2352 x 1568 pixels: 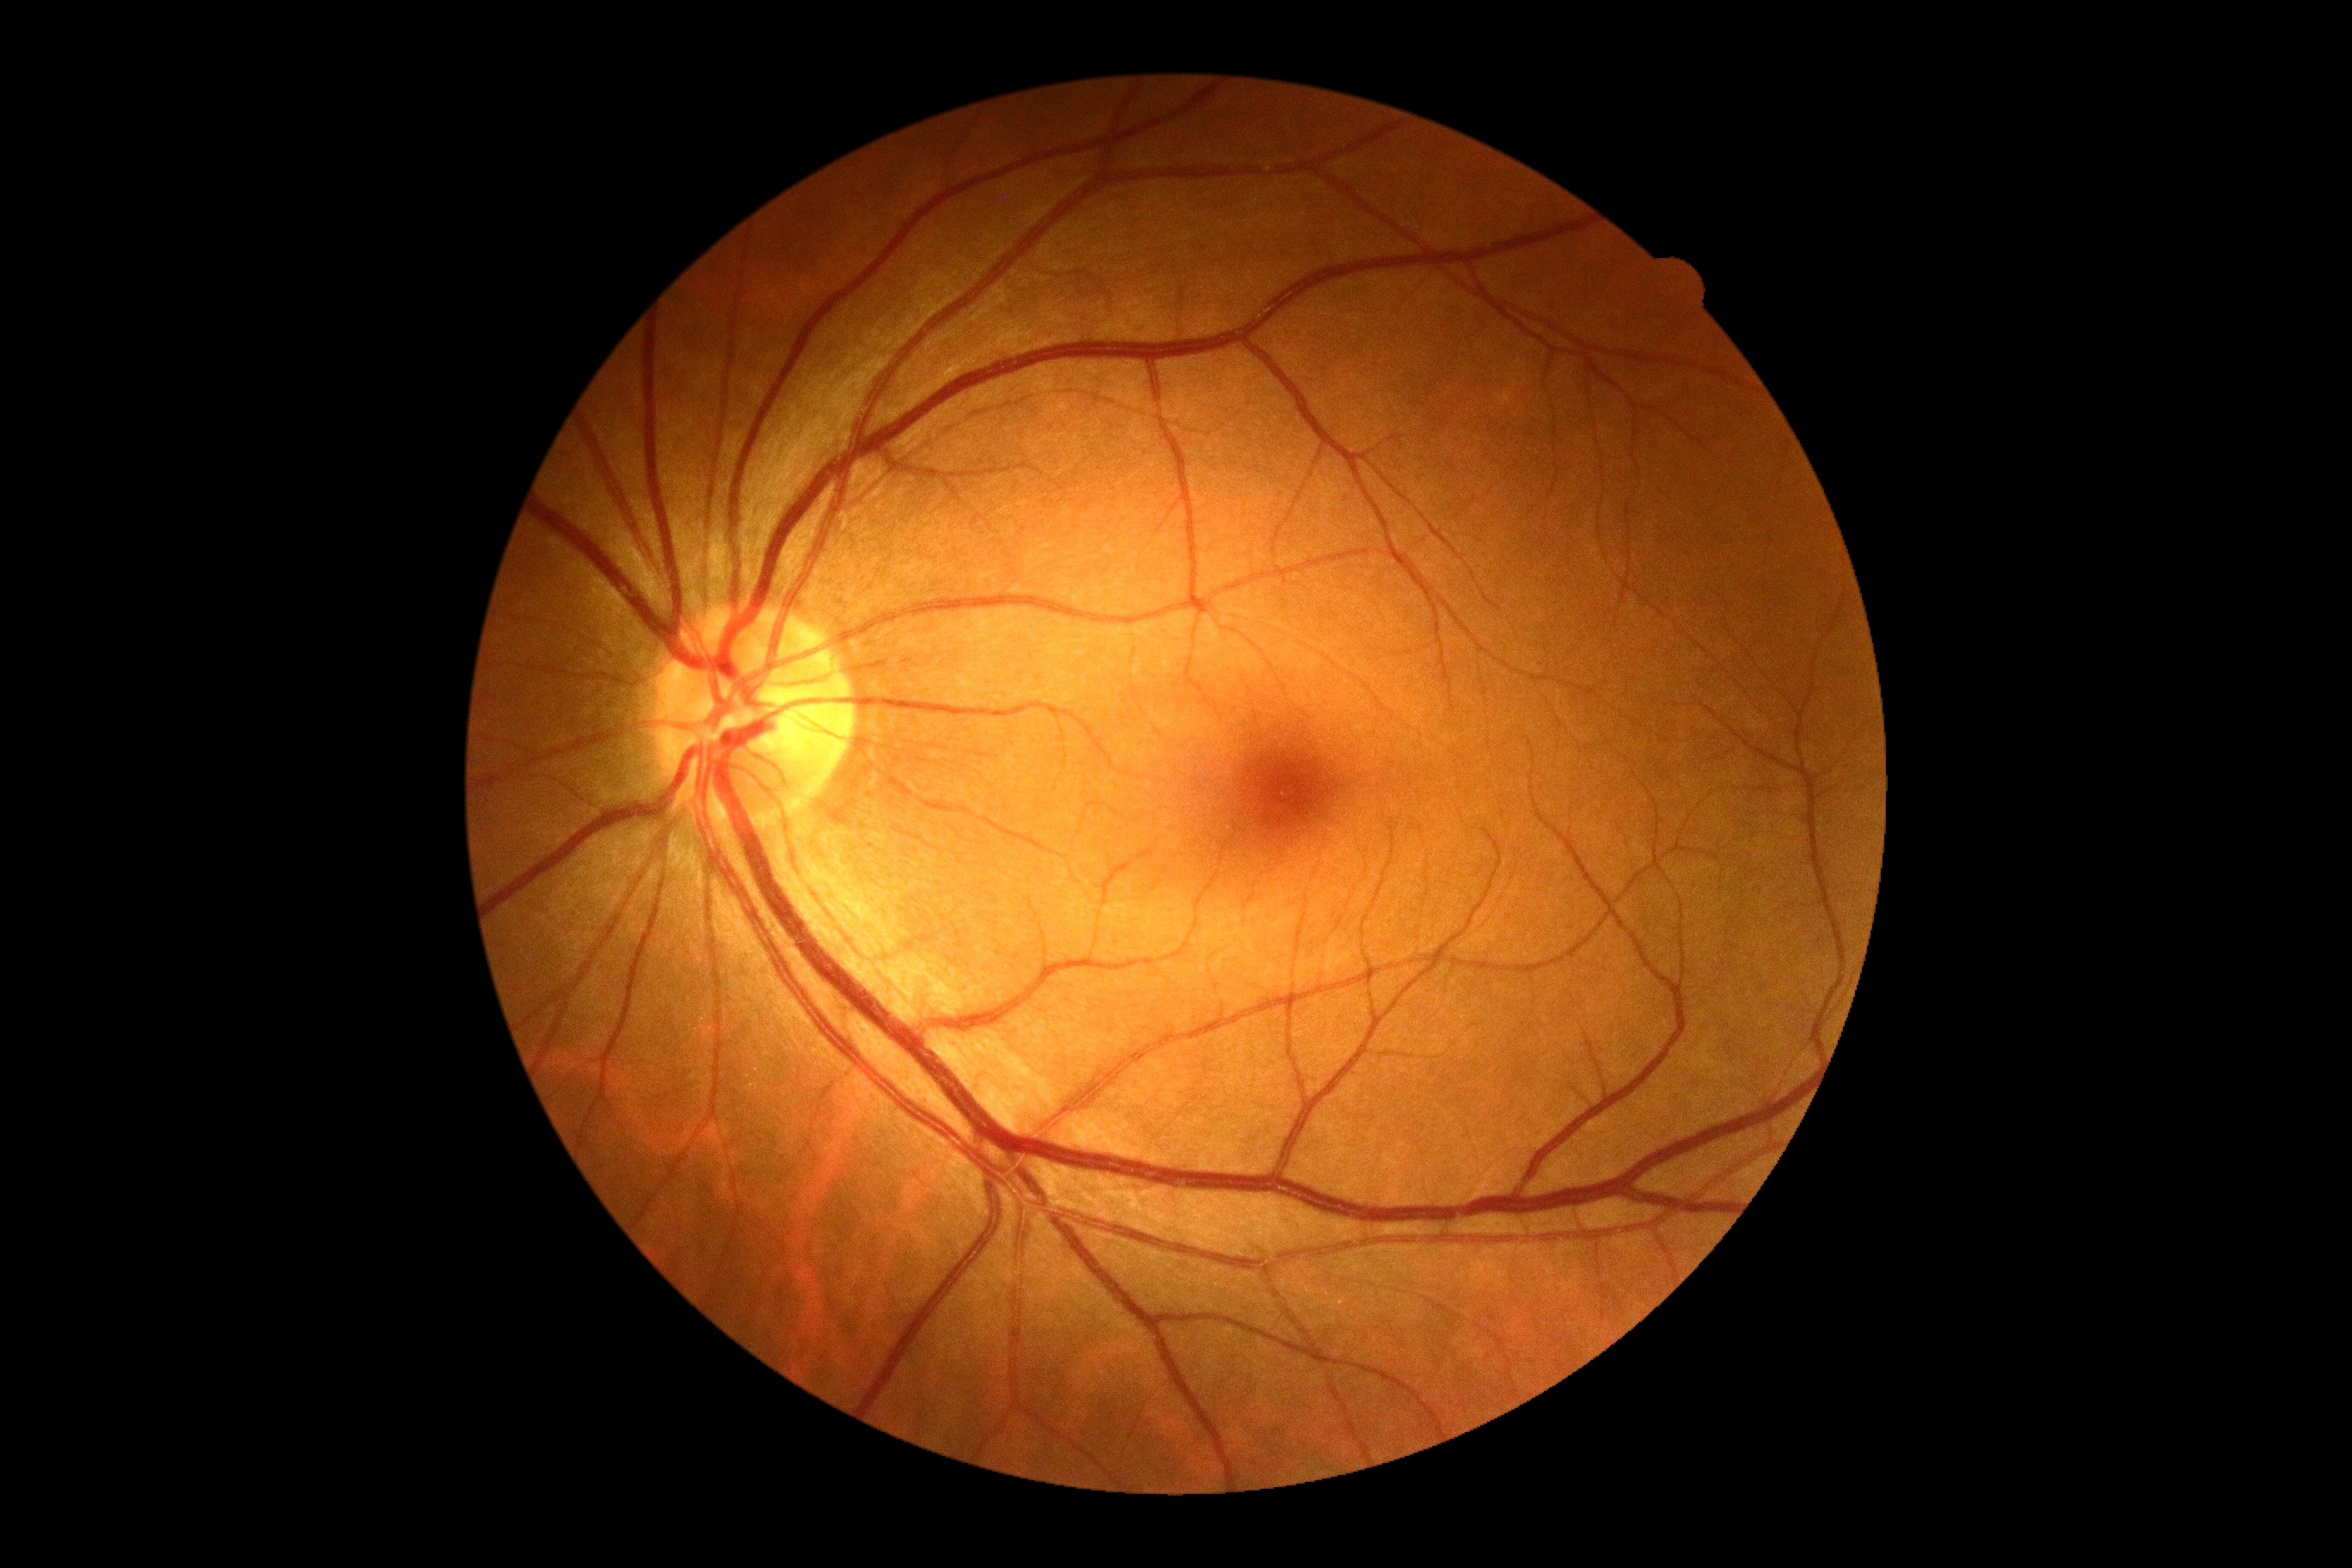 DR severity = no apparent retinopathy (grade 0)